240x240px, Nidek AFC-330
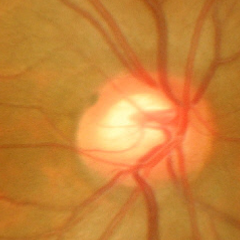 Showing no glaucomatous changes.